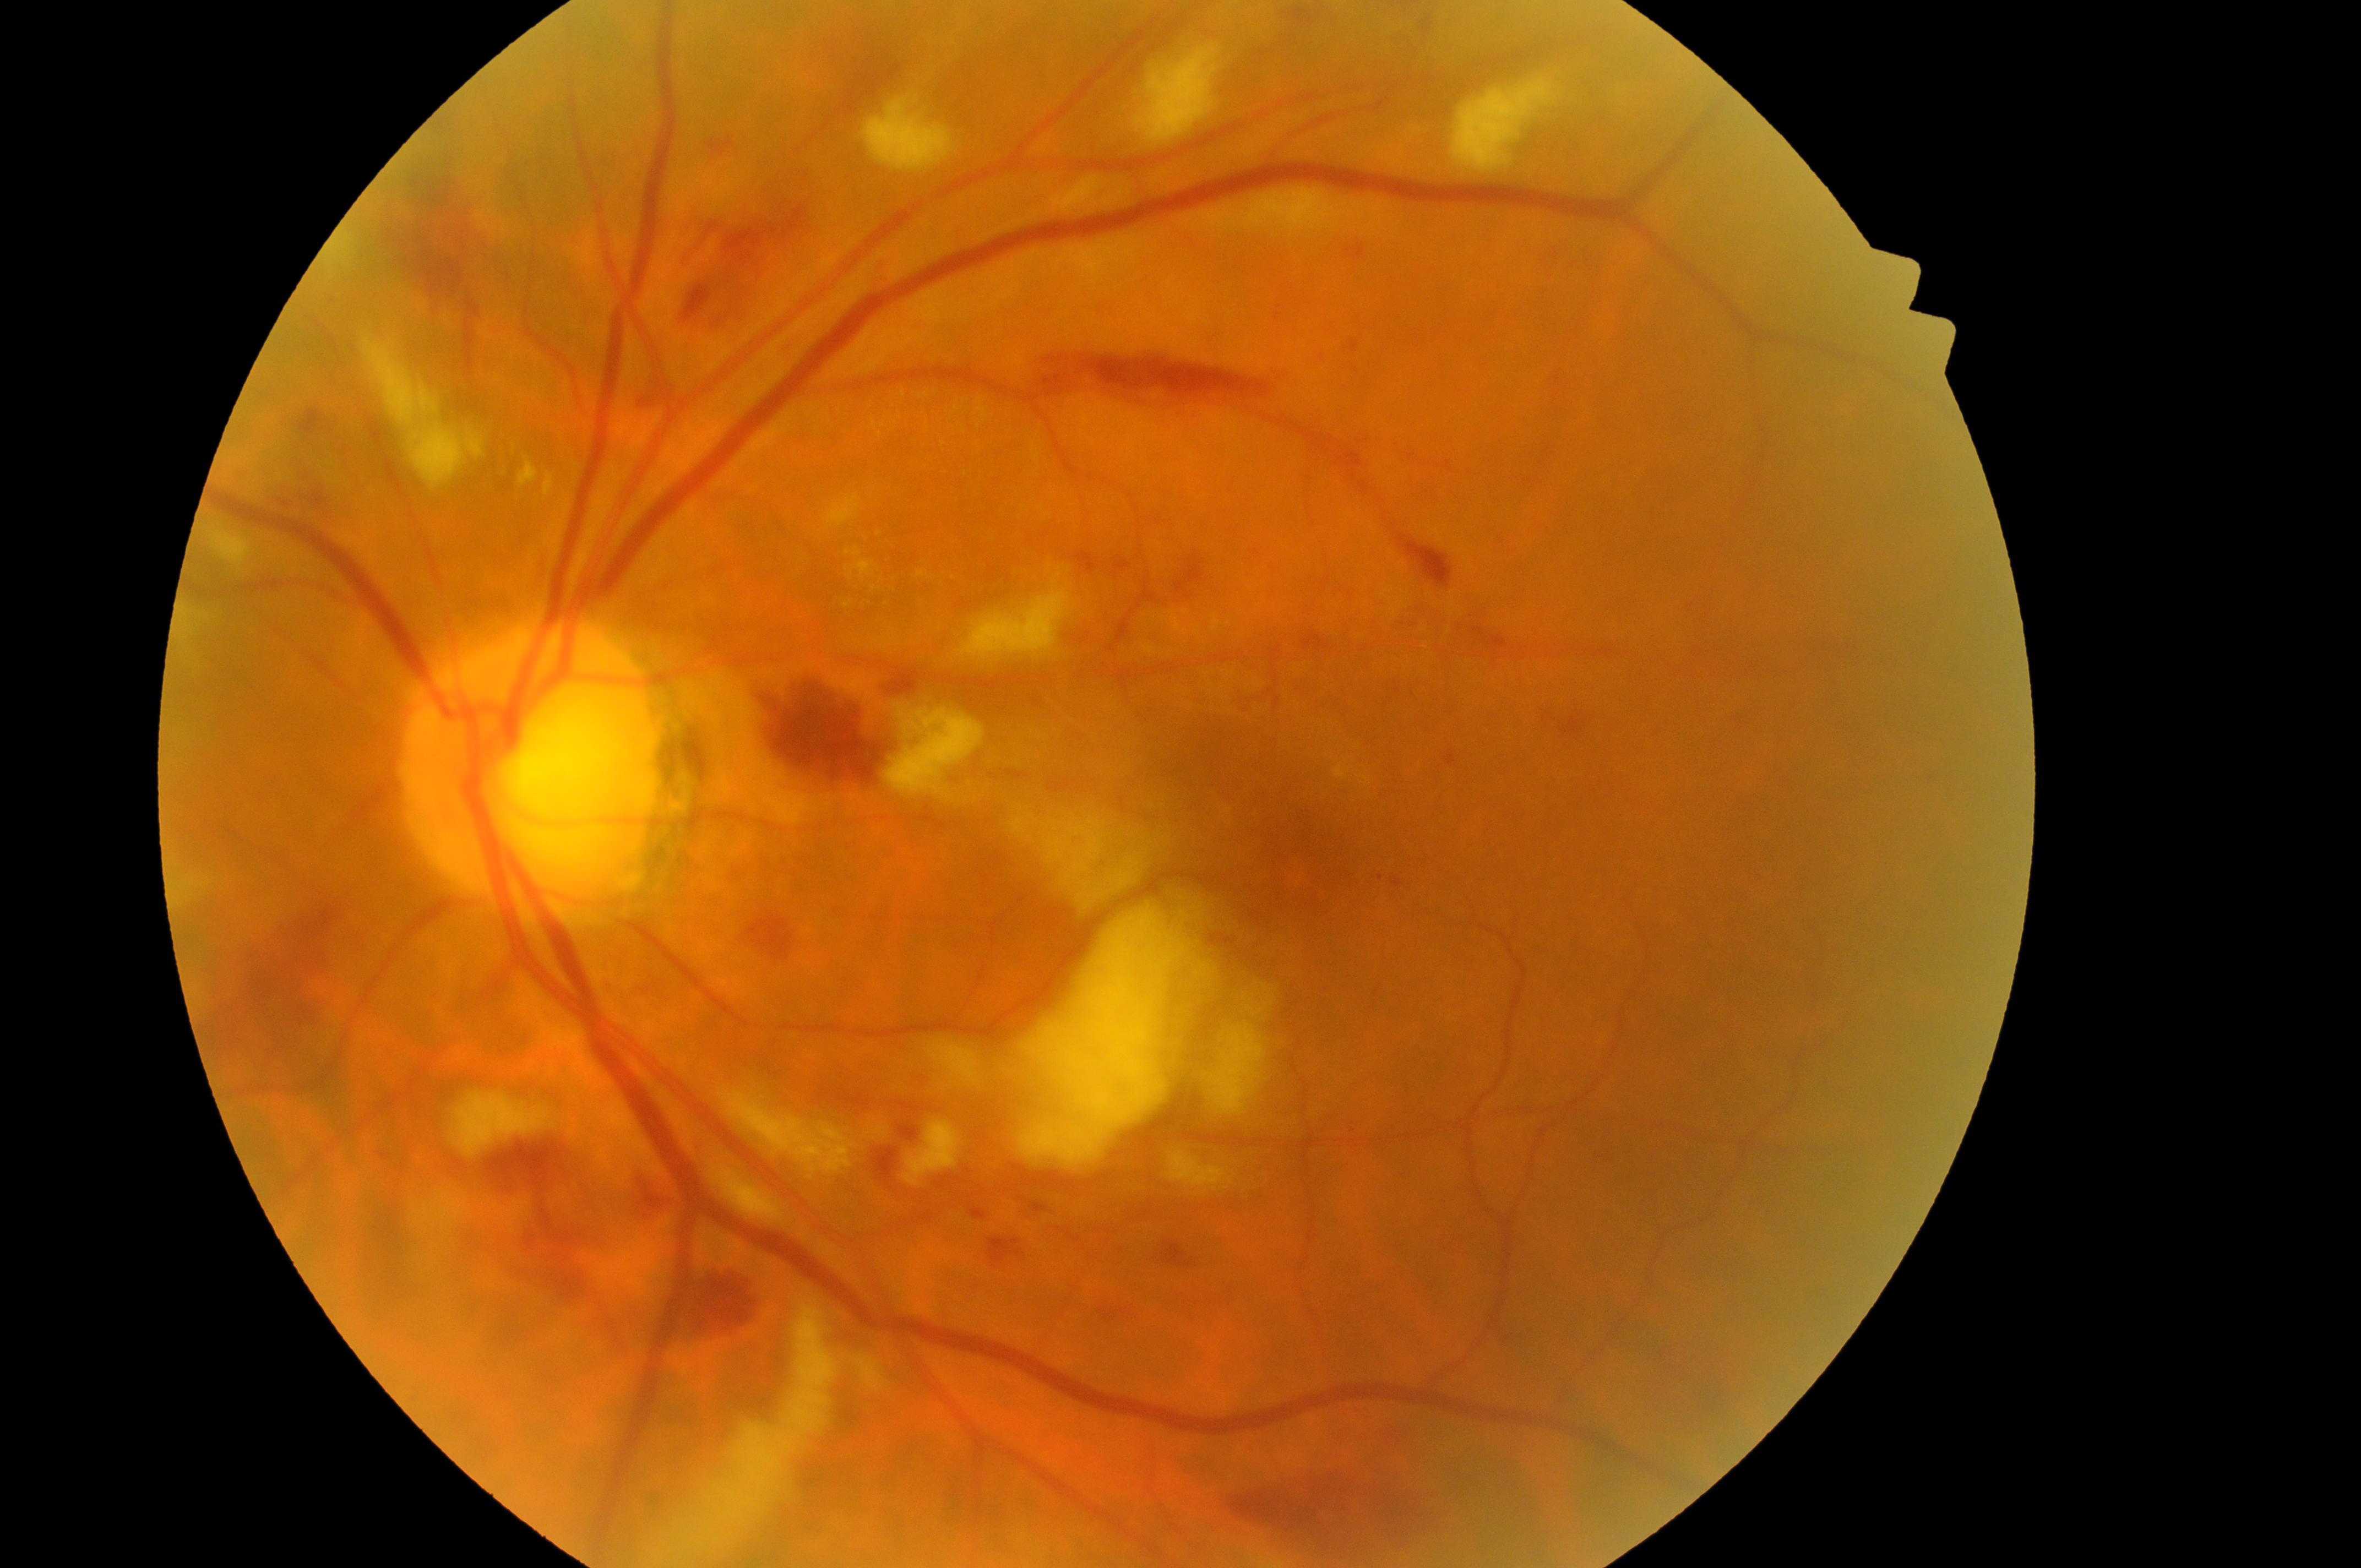

DR severity: 3/4. The image shows the left eye. Optic nerve head located at (x=524, y=775). DME risk: 2/2. Fovea: (x=1303, y=868).